Retinal fundus photograph:
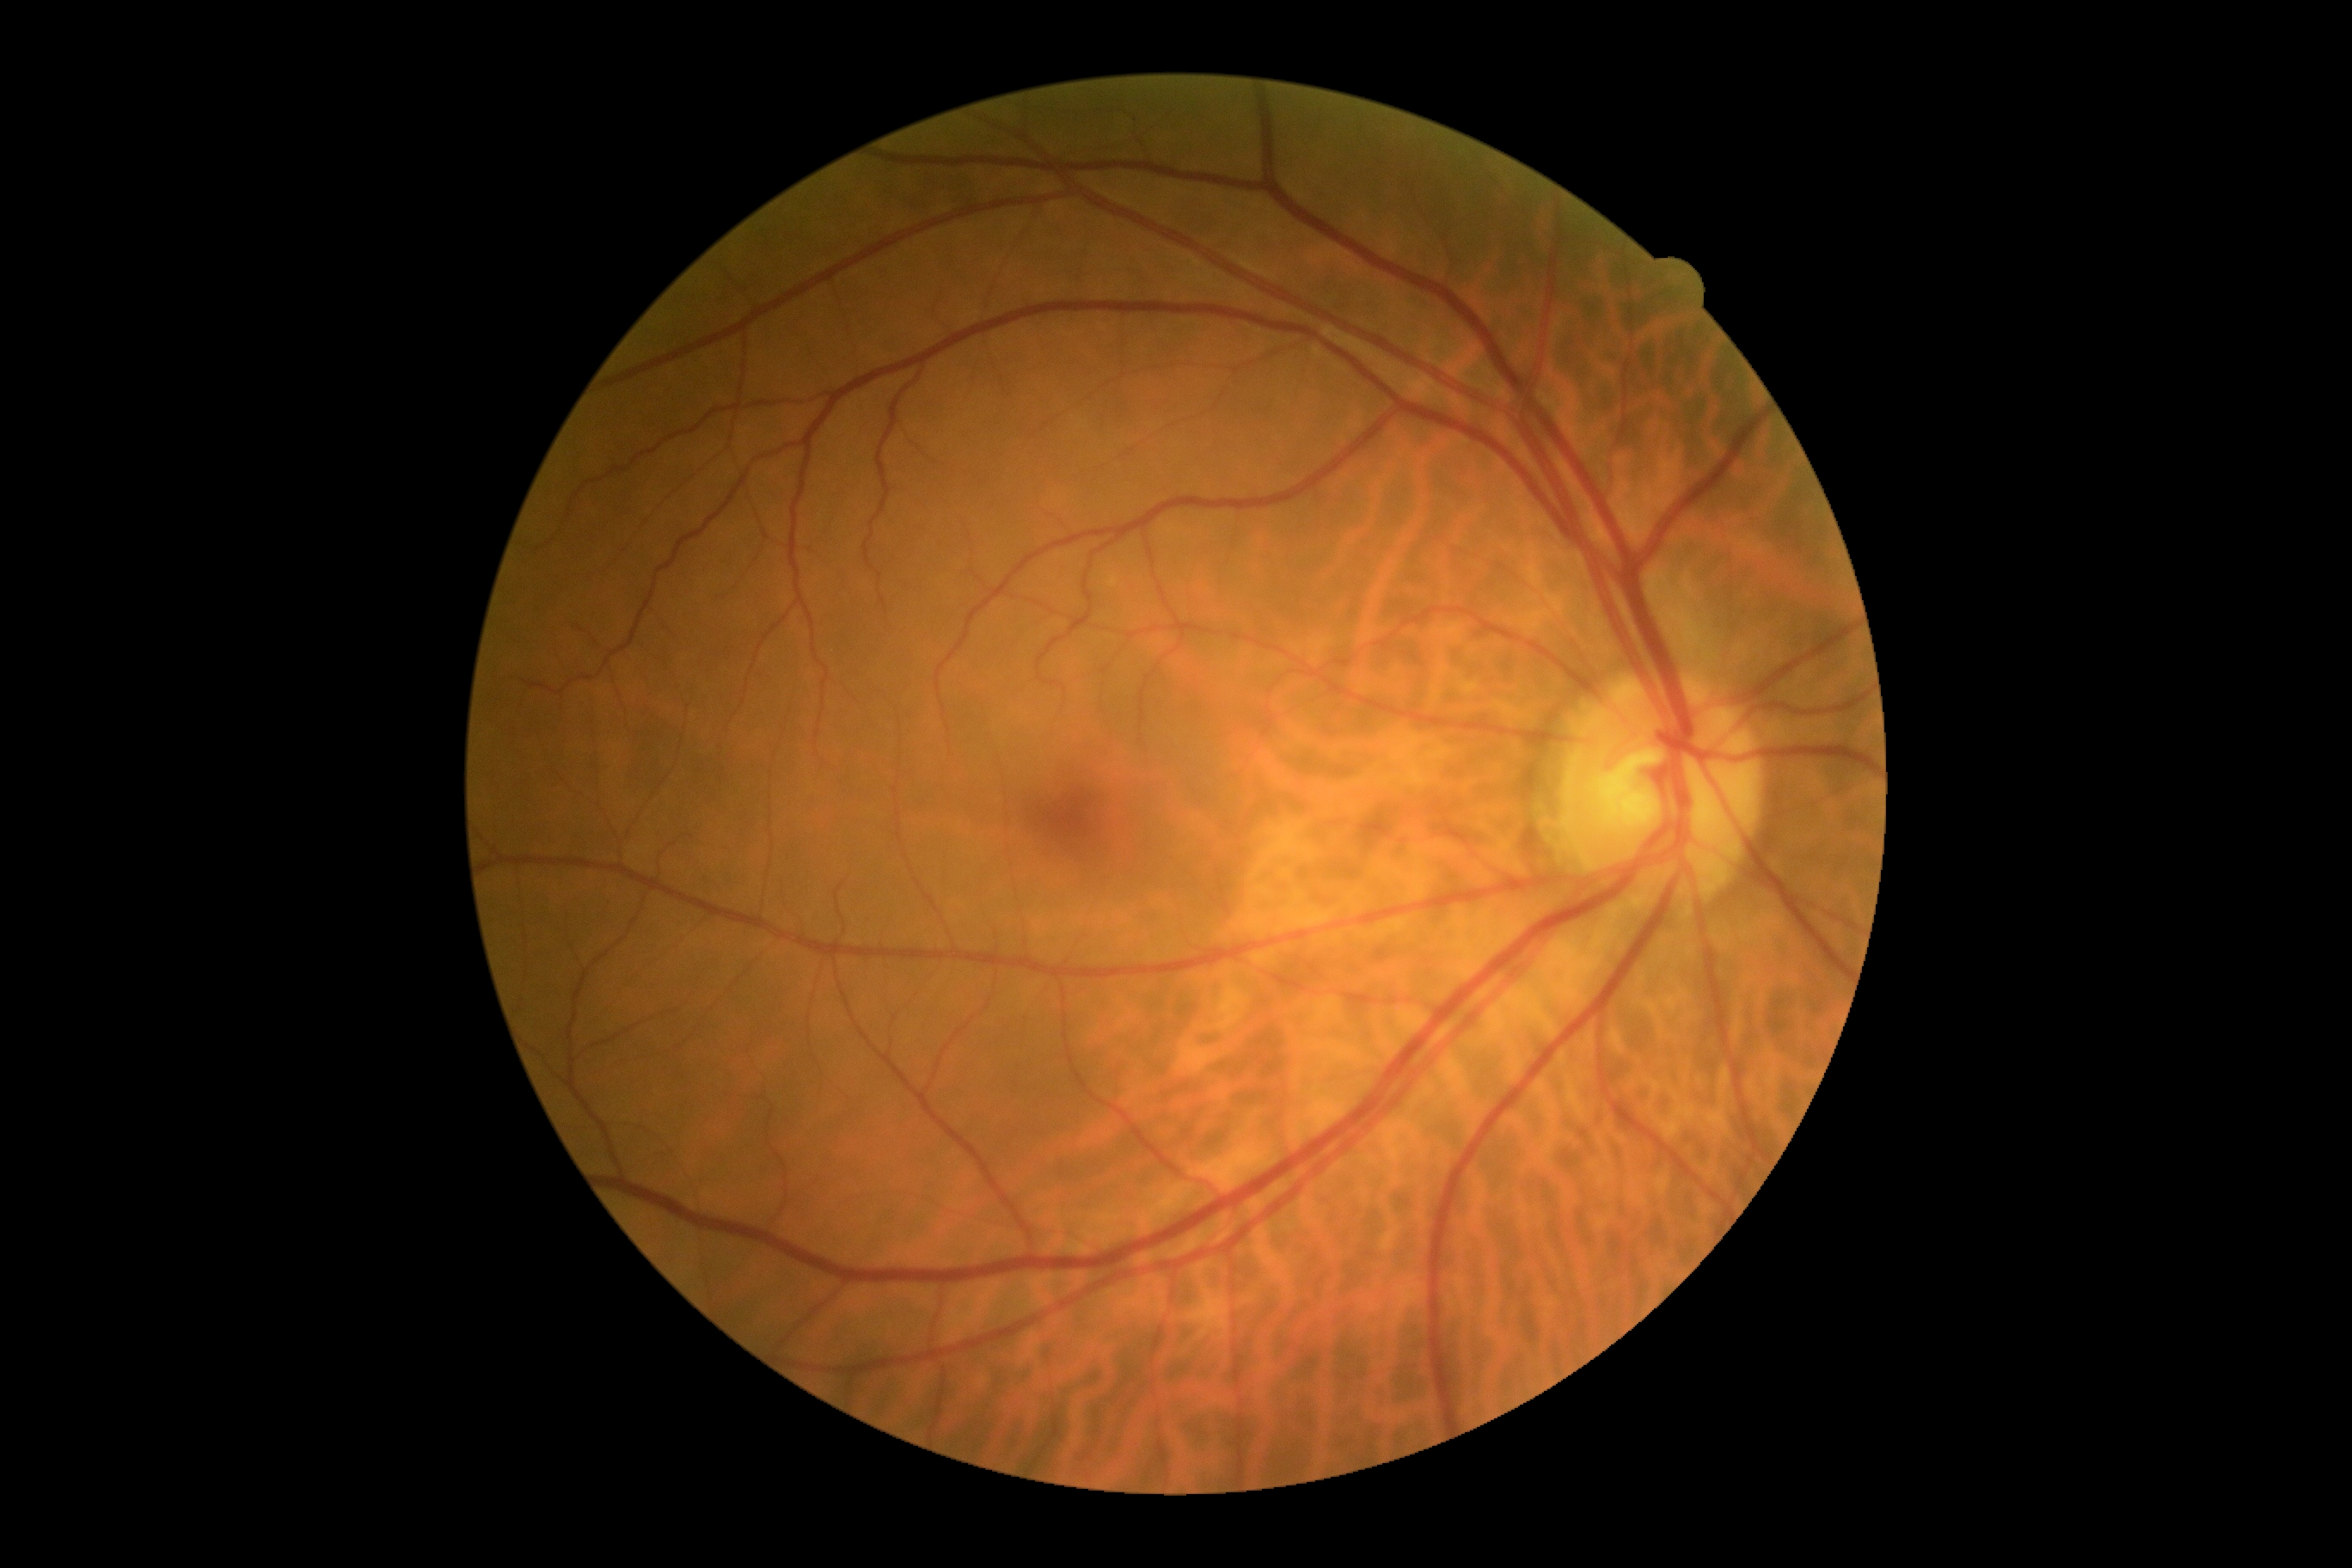
diabetic retinopathy (DR) = grade 0.